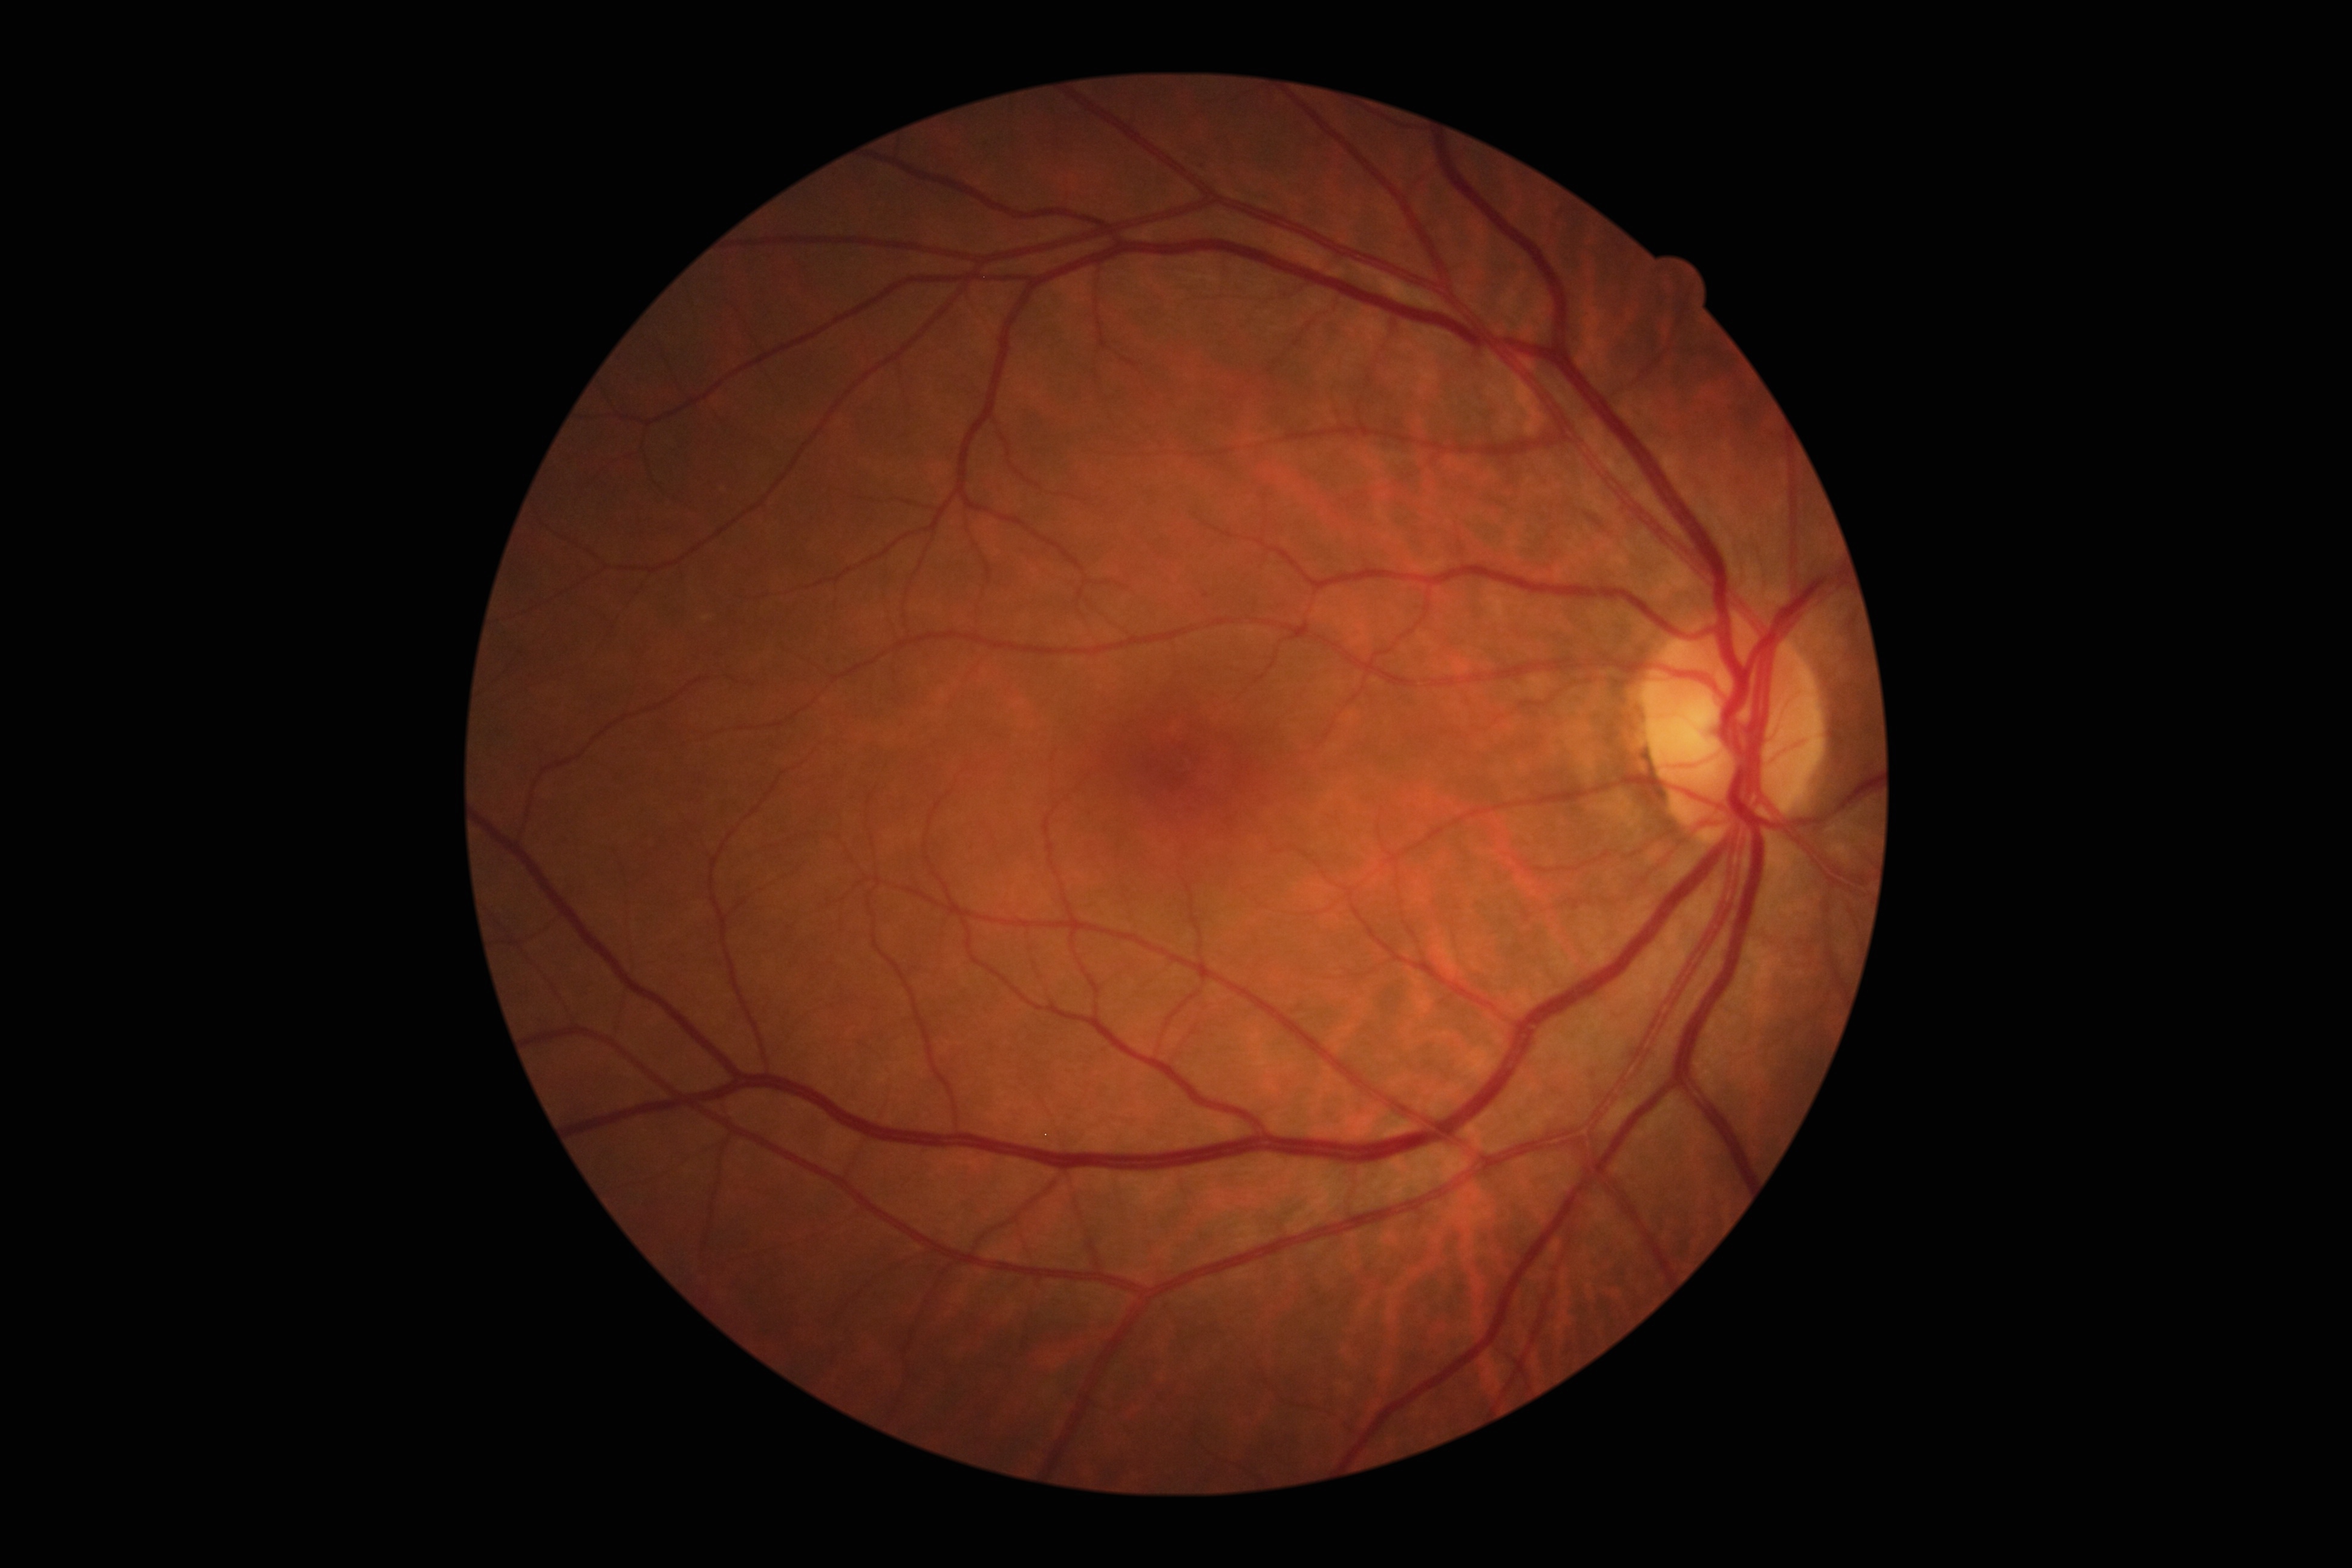

Retinopathy grade is 1.